1240x1240px · Phoenix ICON wide-field infant fundus image · captured with the Phoenix ICON (100° field of view):
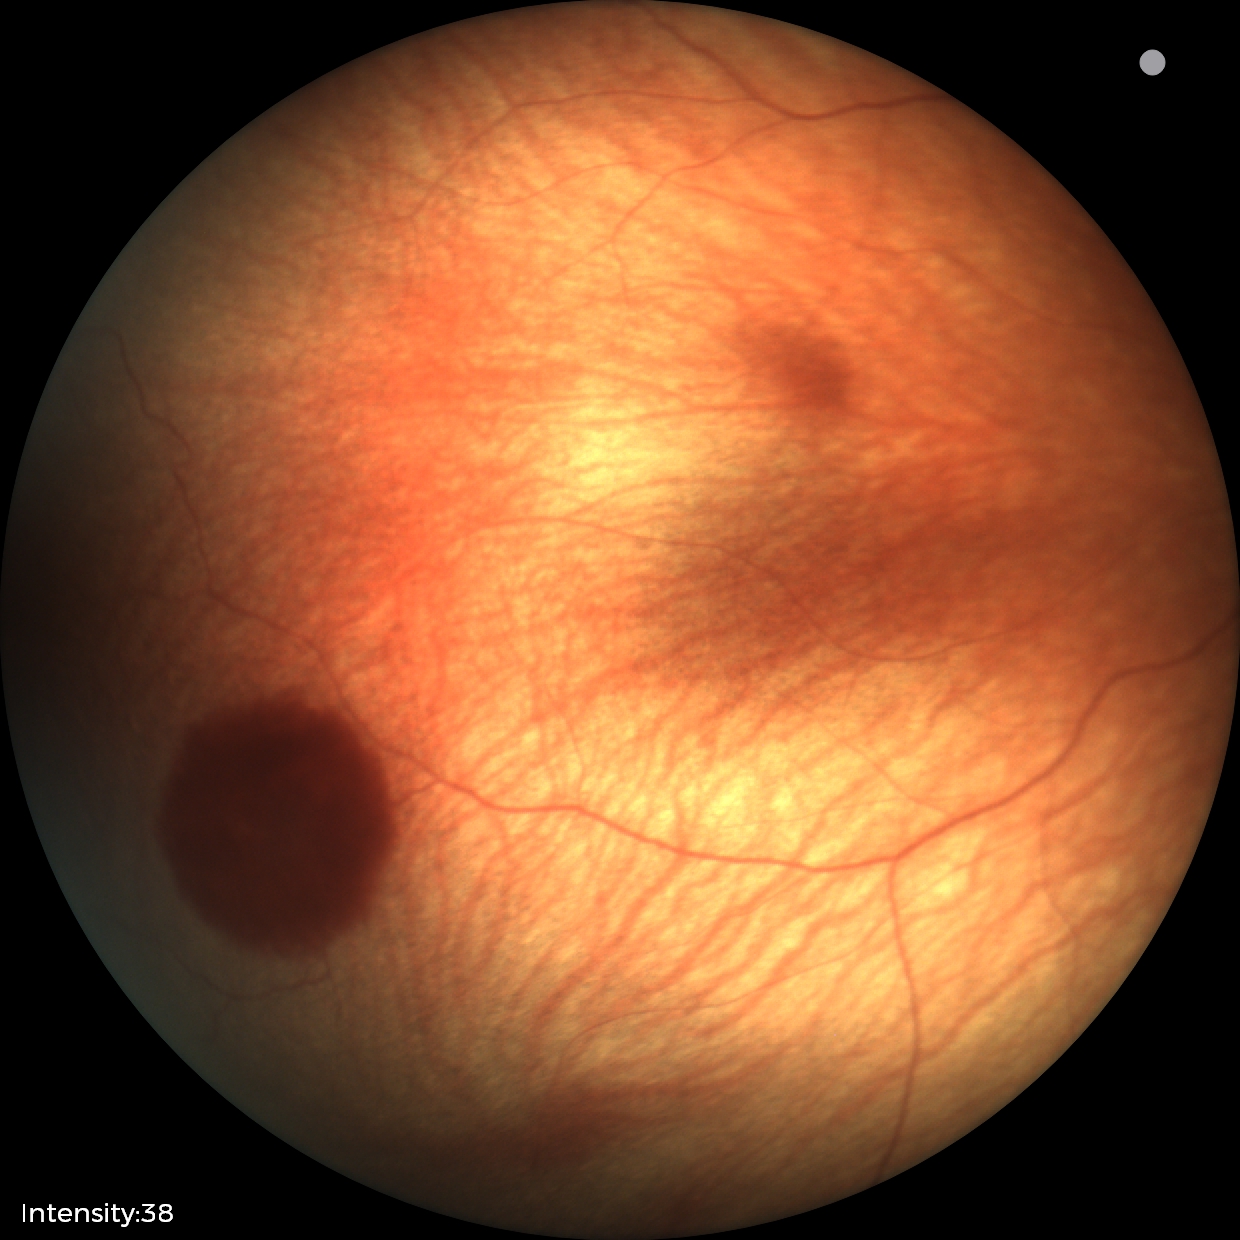 From an examination with diagnosis of retinal hemorrhages.